1240x1240 · Phoenix ICON, 100° FOV · wide-field fundus photograph of an infant.
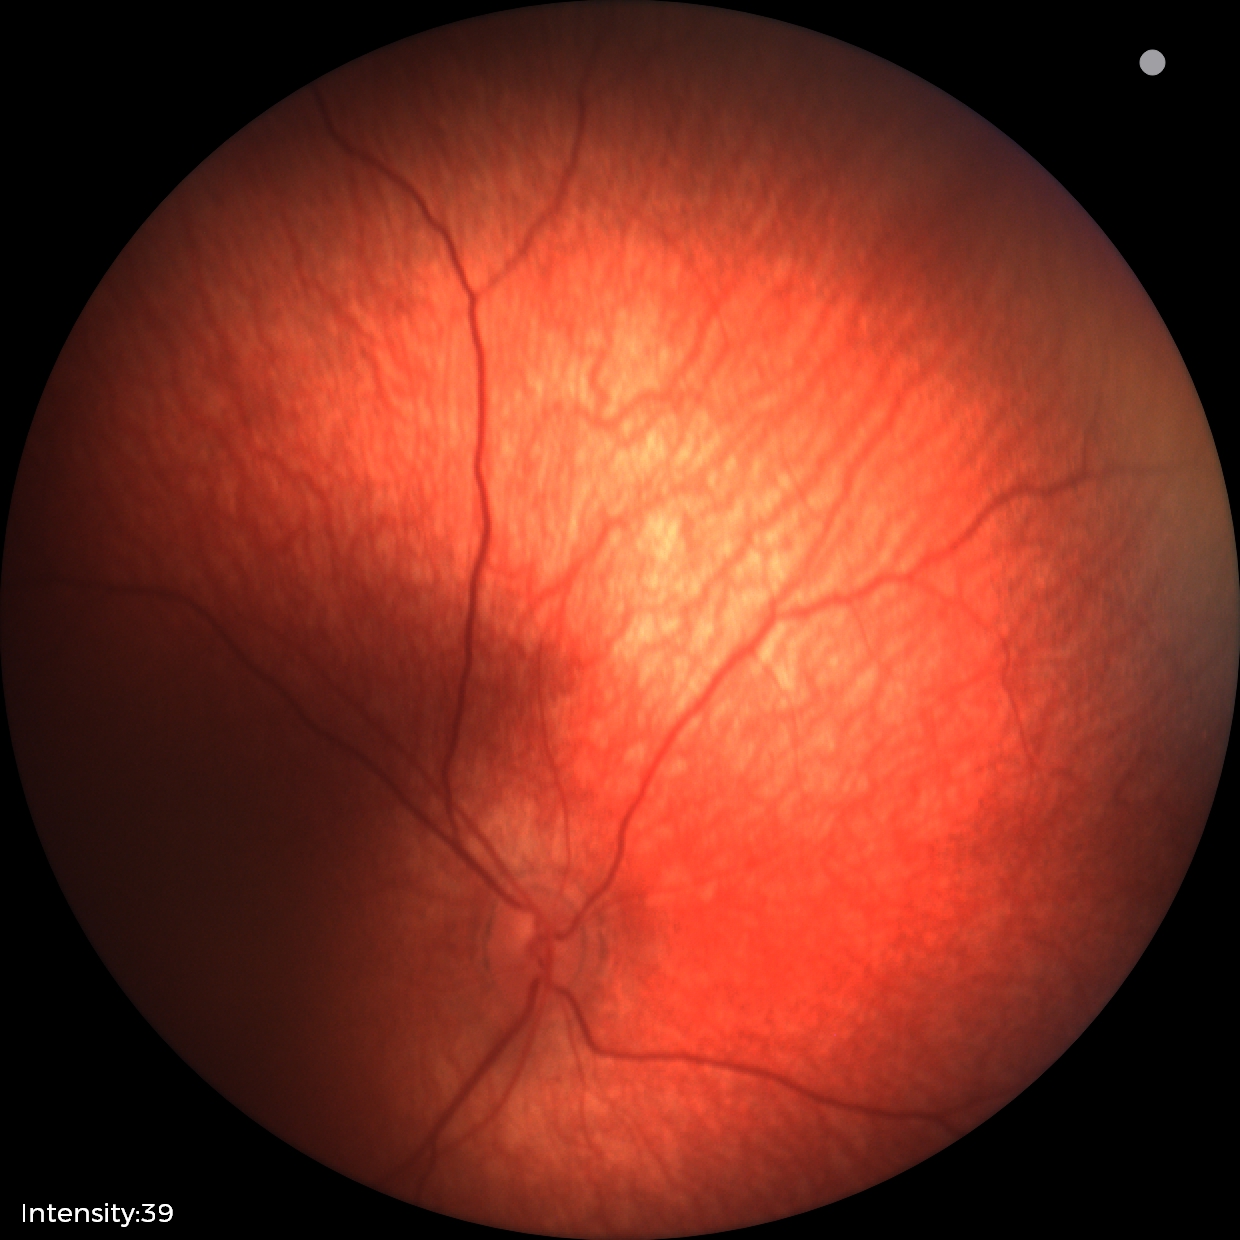
Screening examination diagnosed as physiological.